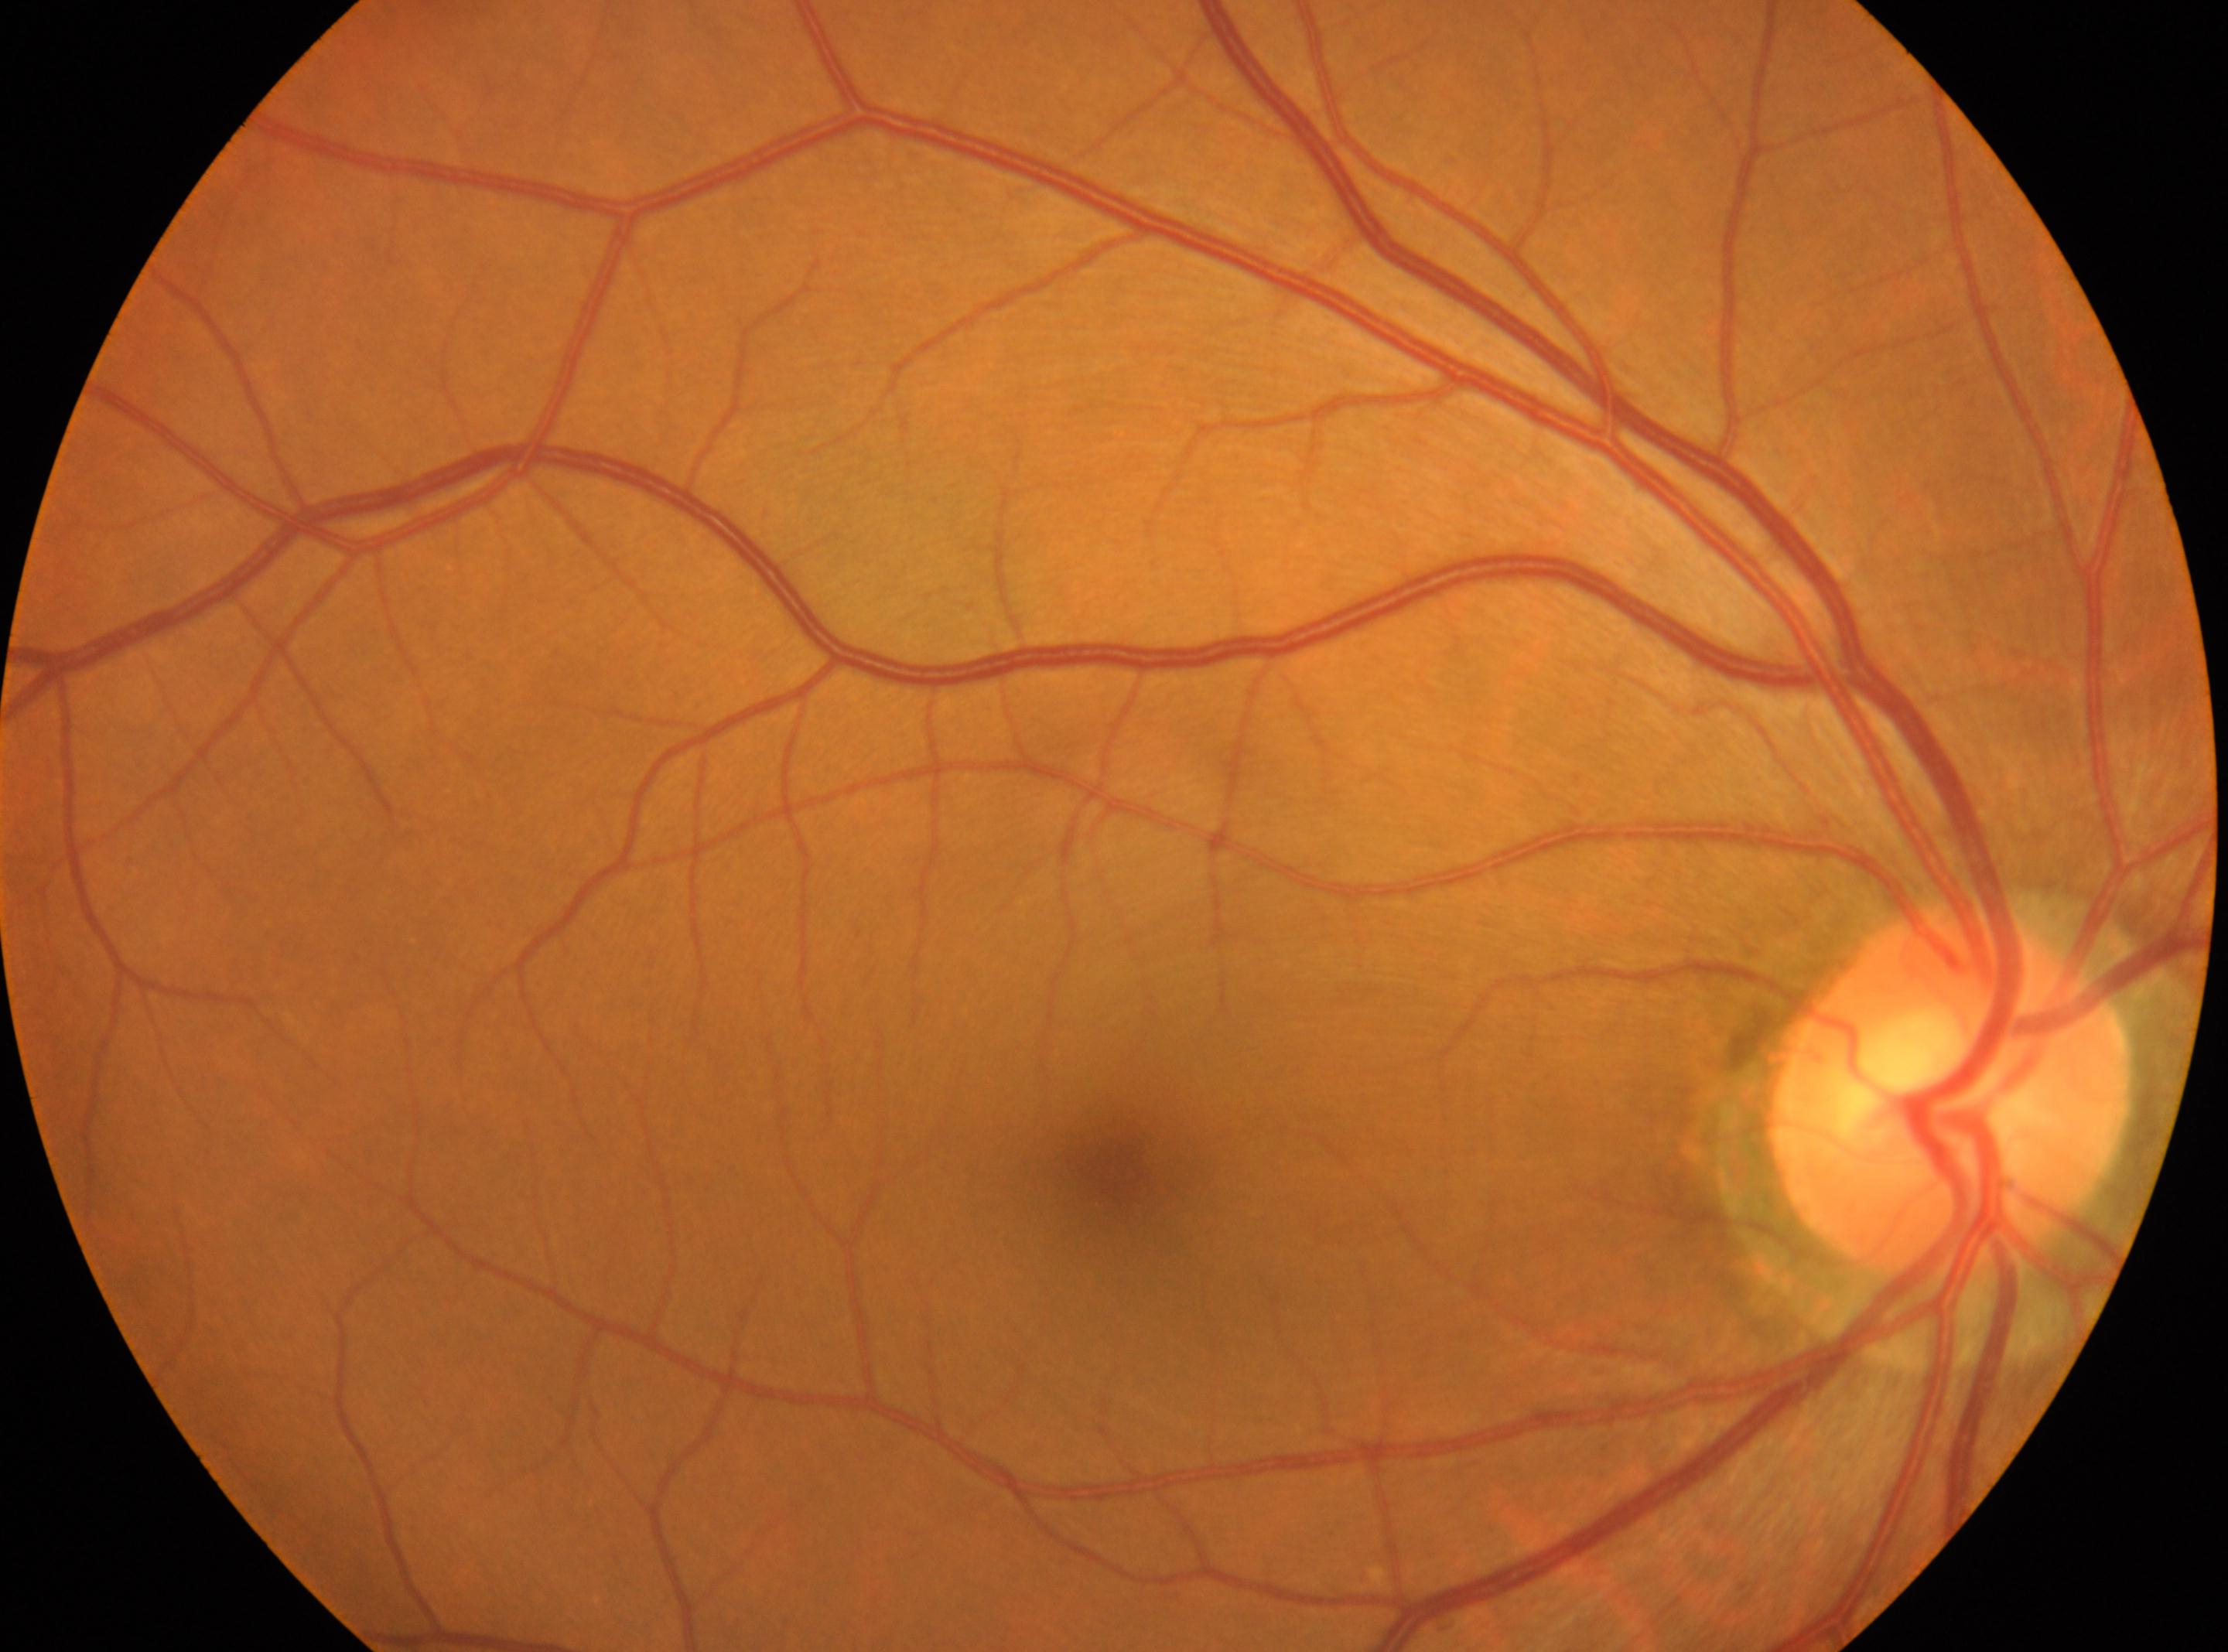 The image shows the OD. Diabetic retinopathy severity: grade 0 (no apparent retinopathy). Disc center located at (x: 1950, y: 1091). The fovea centralis is at (x: 1109, y: 1172). No diabetic retinal disease findings.